DR severity per modified Davis staging
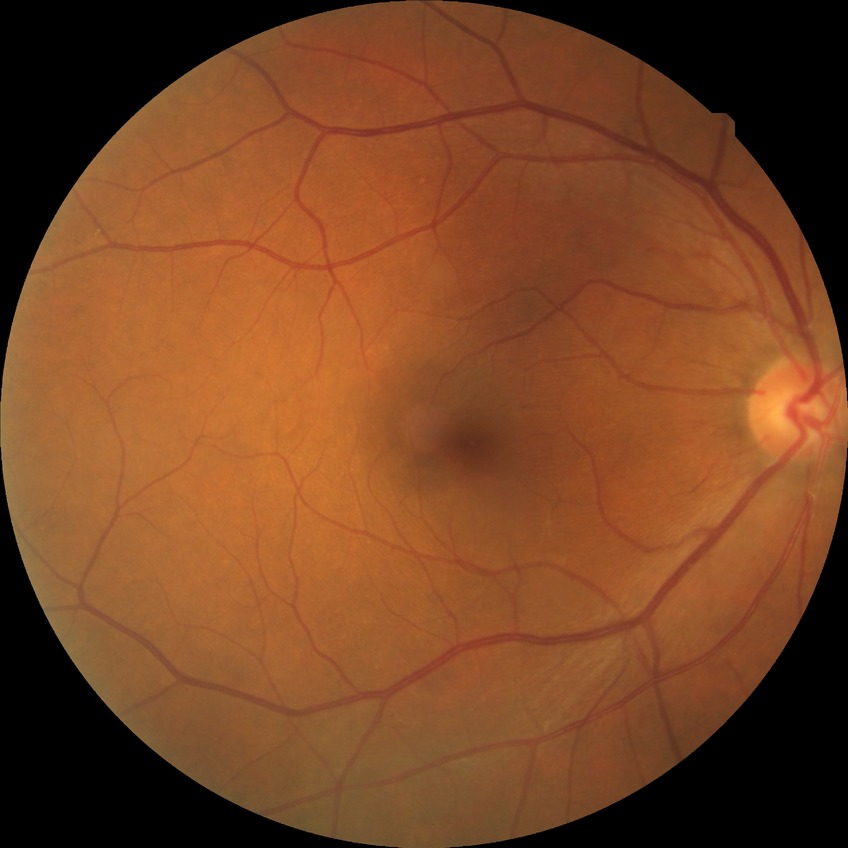
Diabetic retinopathy (DR) is no diabetic retinopathy (NDR).